45° field of view. NIDEK AFC-230 fundus camera. Retinal fundus photograph
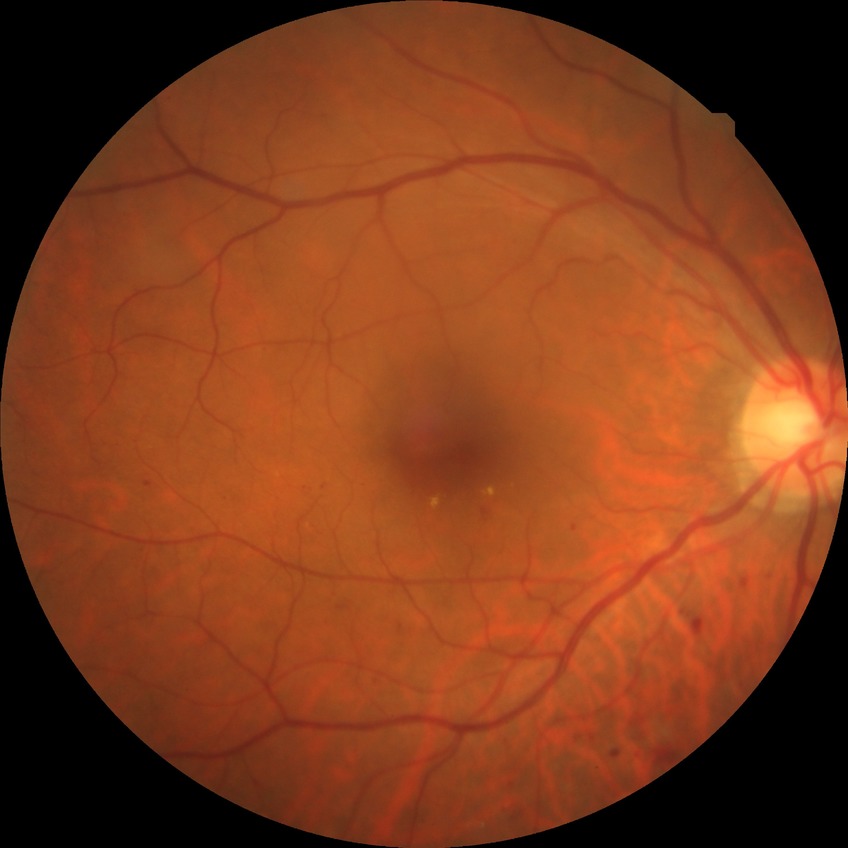 Retinopathy stage is simple diabetic retinopathy.